Image size 2352x1568, 45-degree field of view
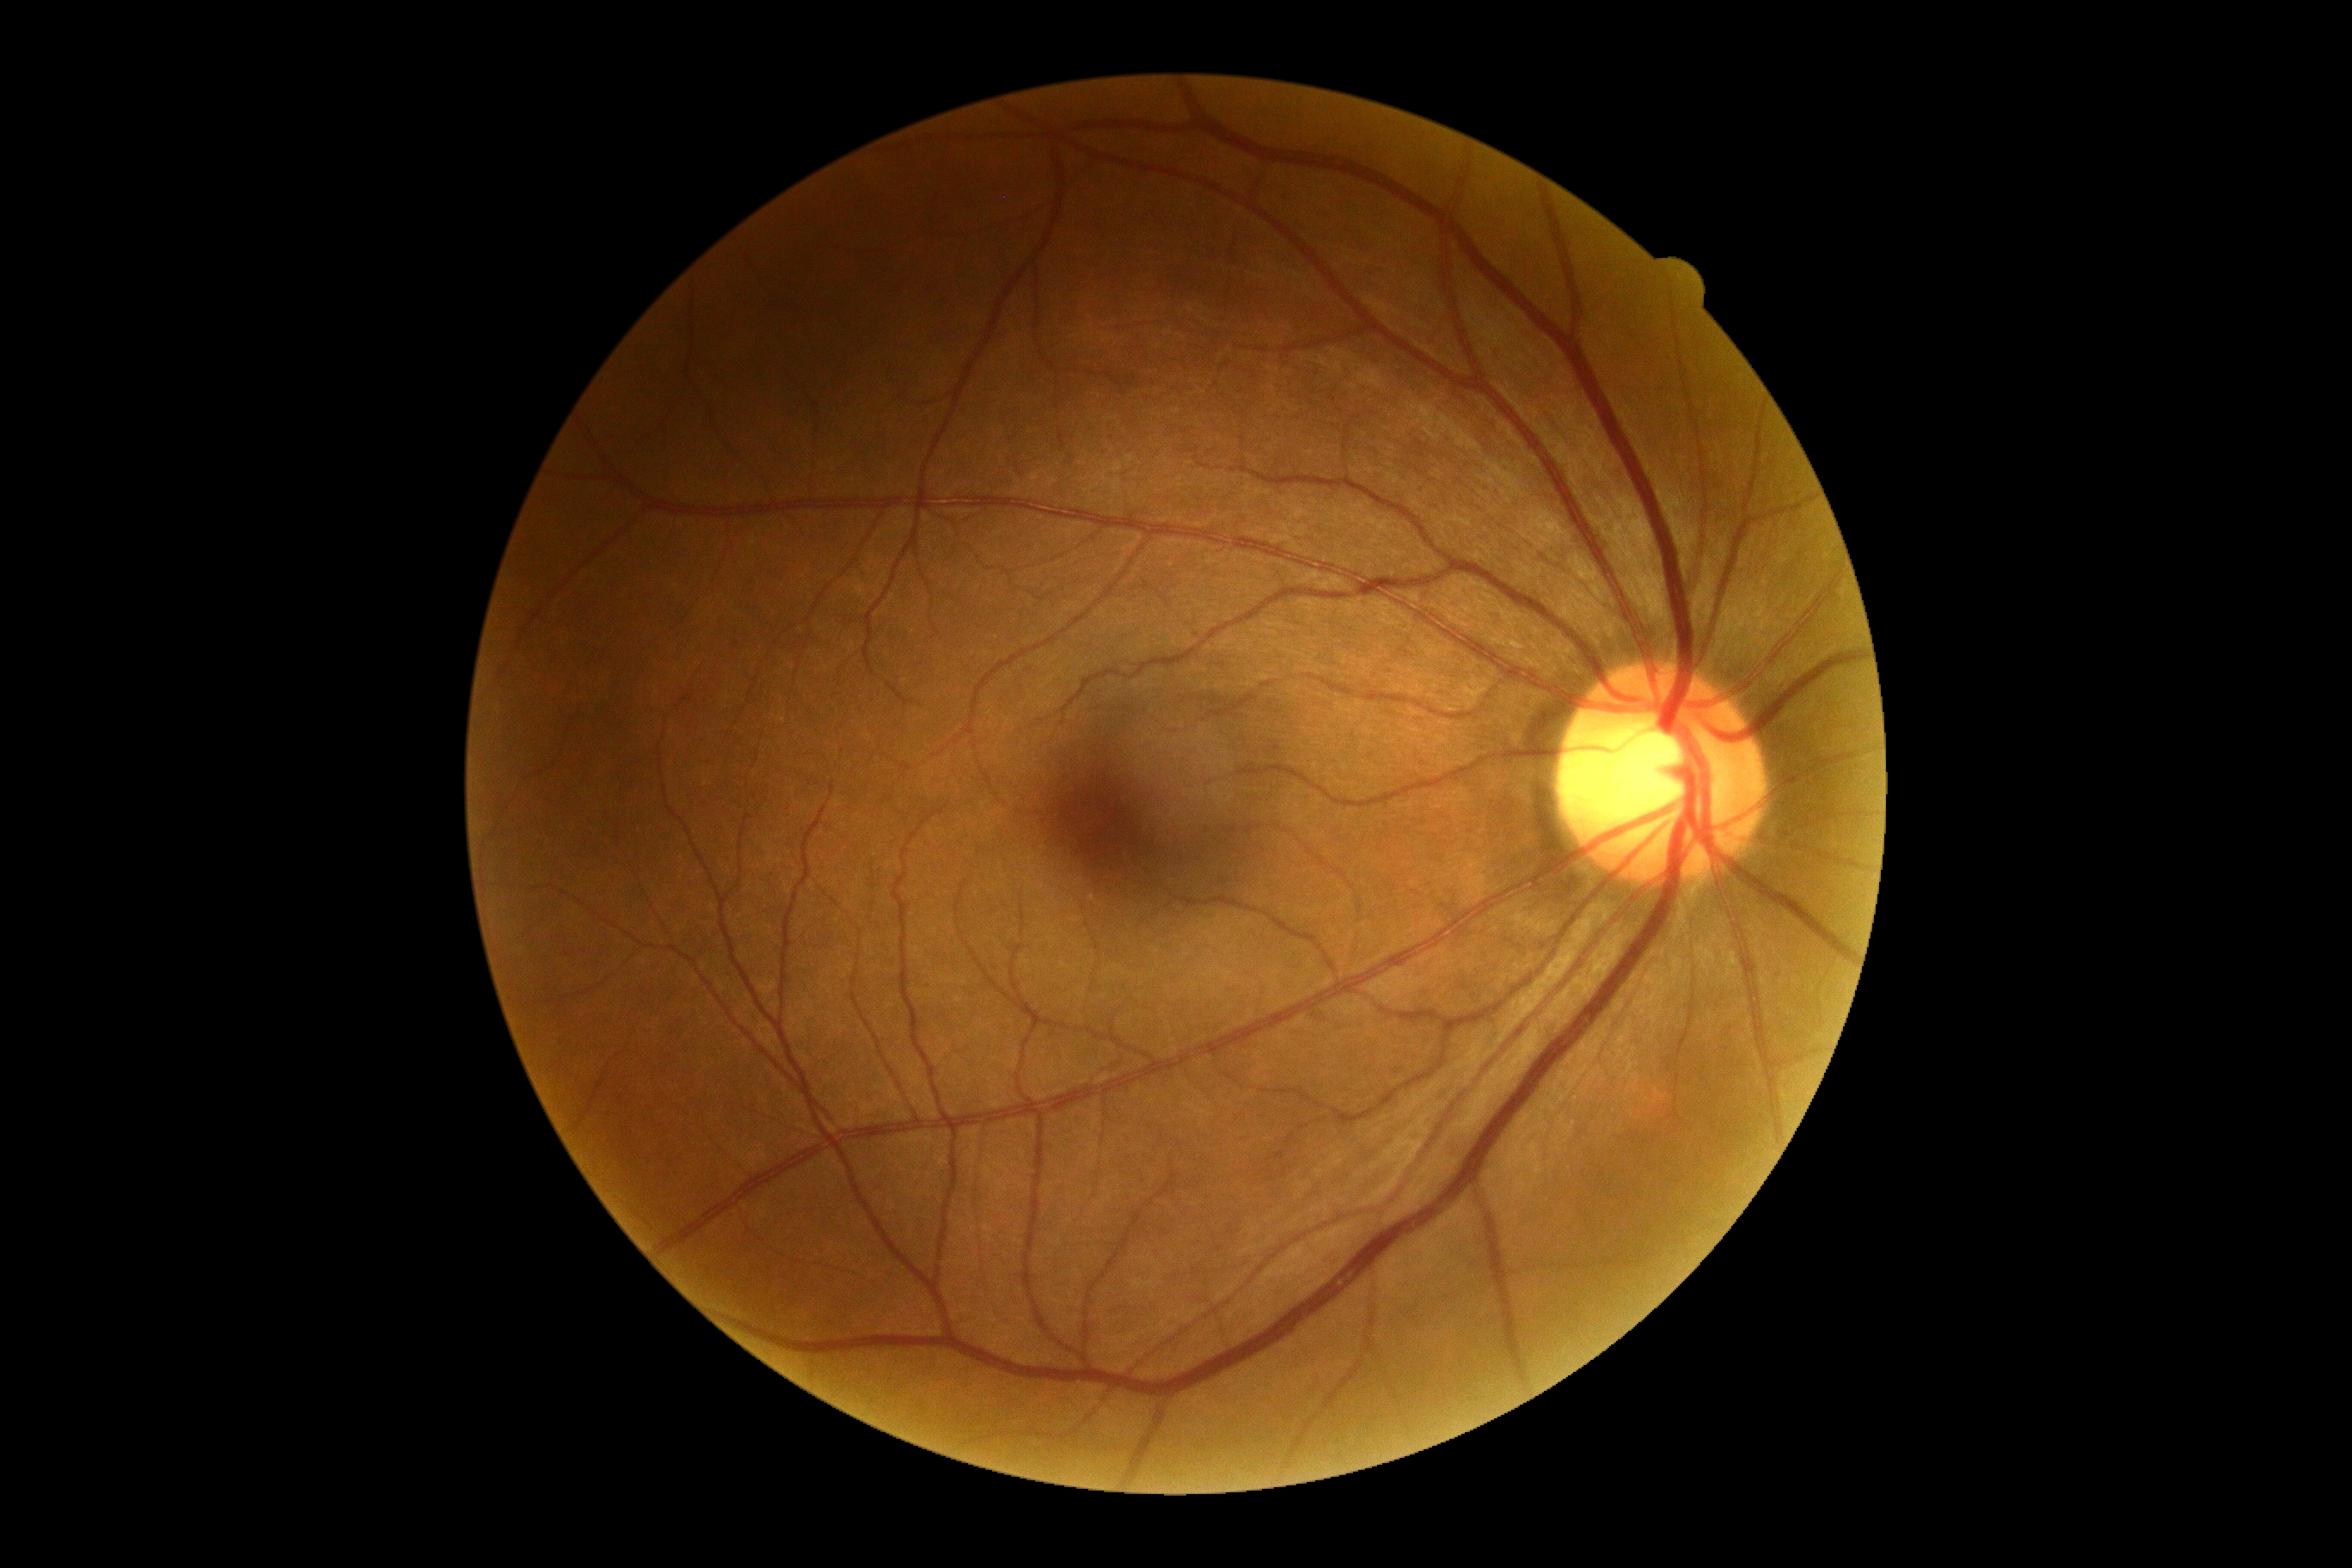

Diabetic retinopathy severity: 0. No apparent diabetic retinopathy.